Non-mydriatic
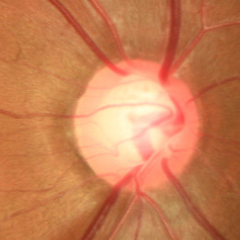 Fundus appearance consistent with early glaucoma.